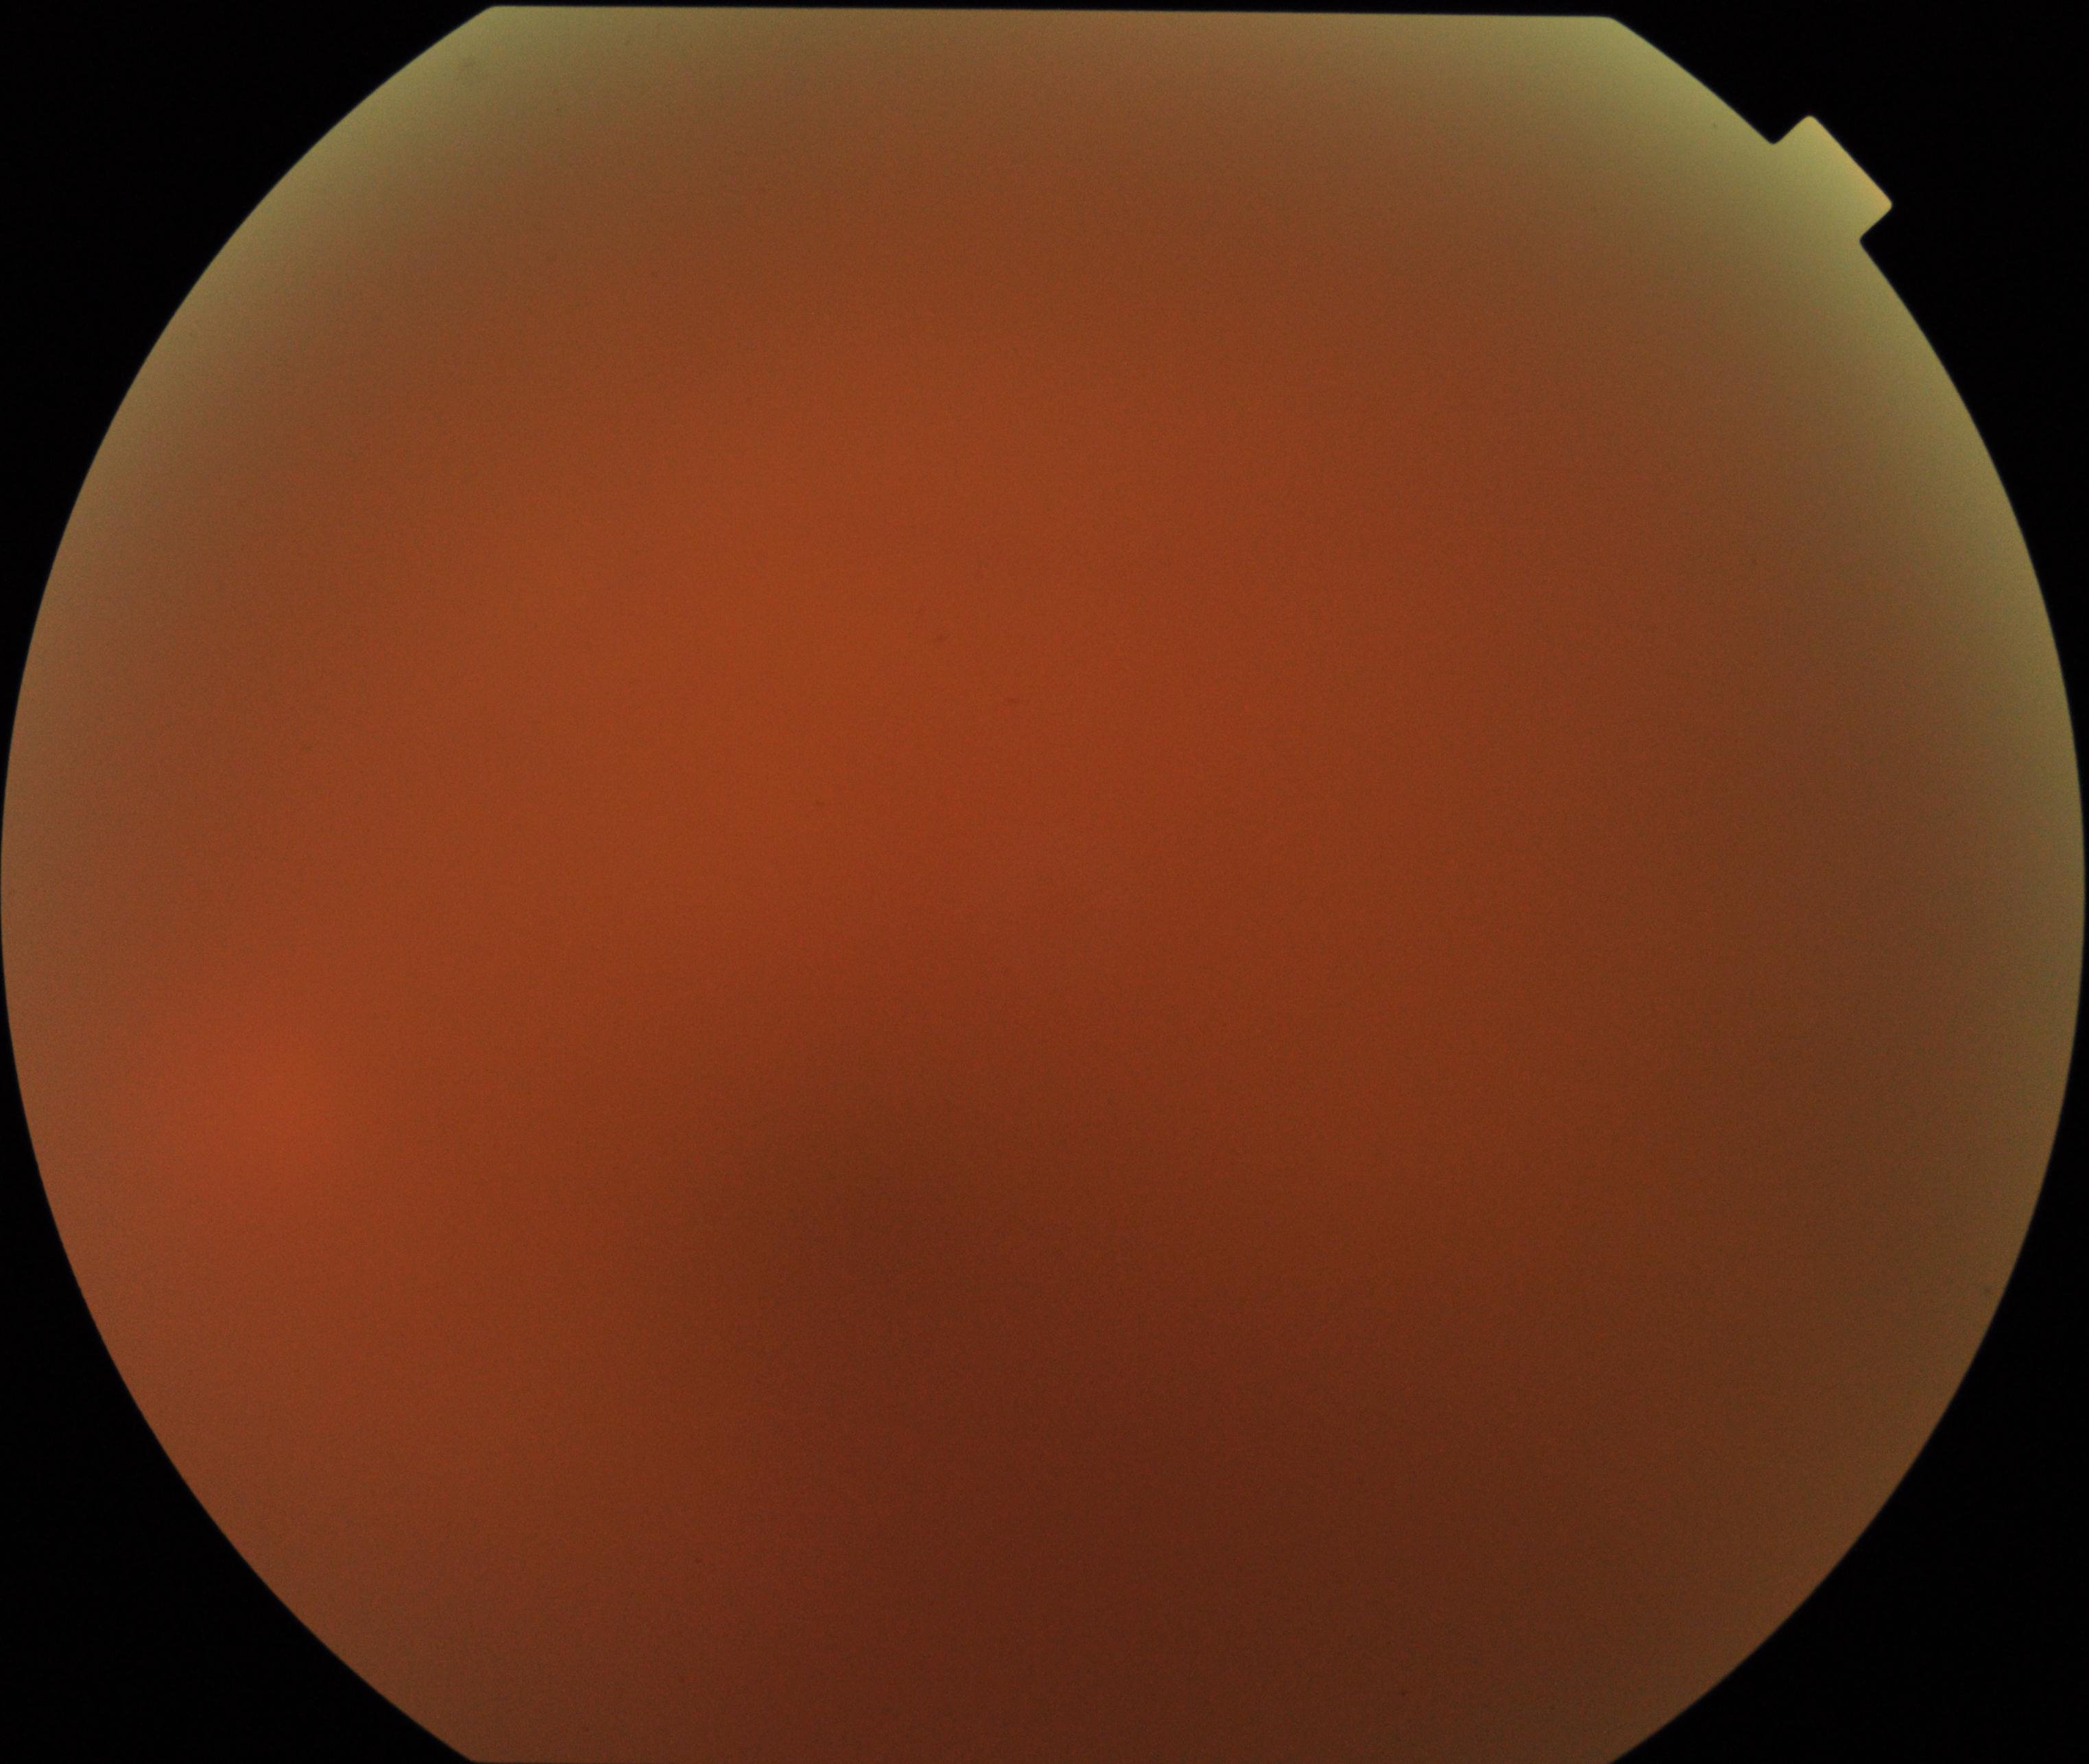

Image quality: blurred, more than half the field obscured.
Proliferative diabetic retinopathy: no evidence.